Posterior pole photograph
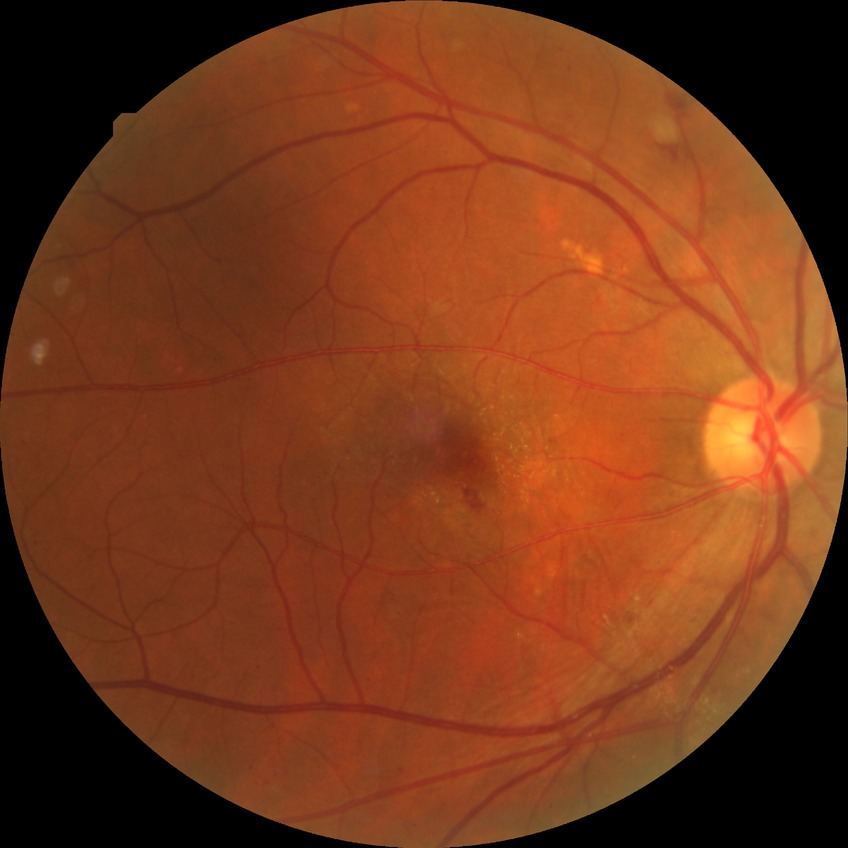
DR: PPDR.